RetCam wide-field infant fundus image — 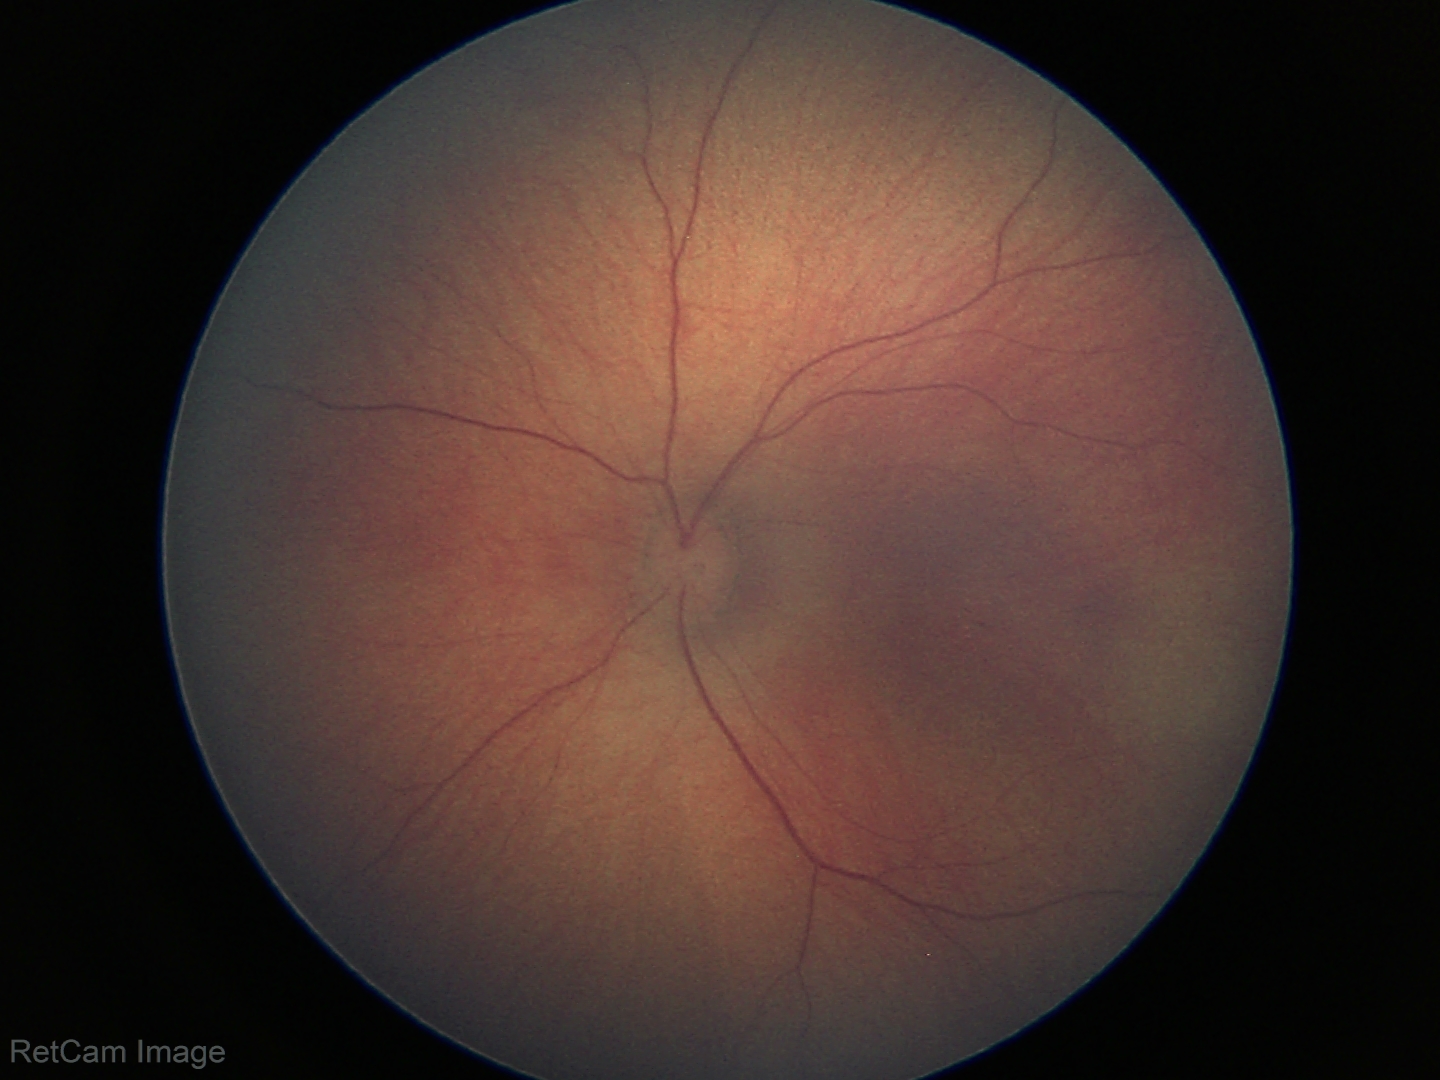
Impression: physiological appearance with no retinal pathology.